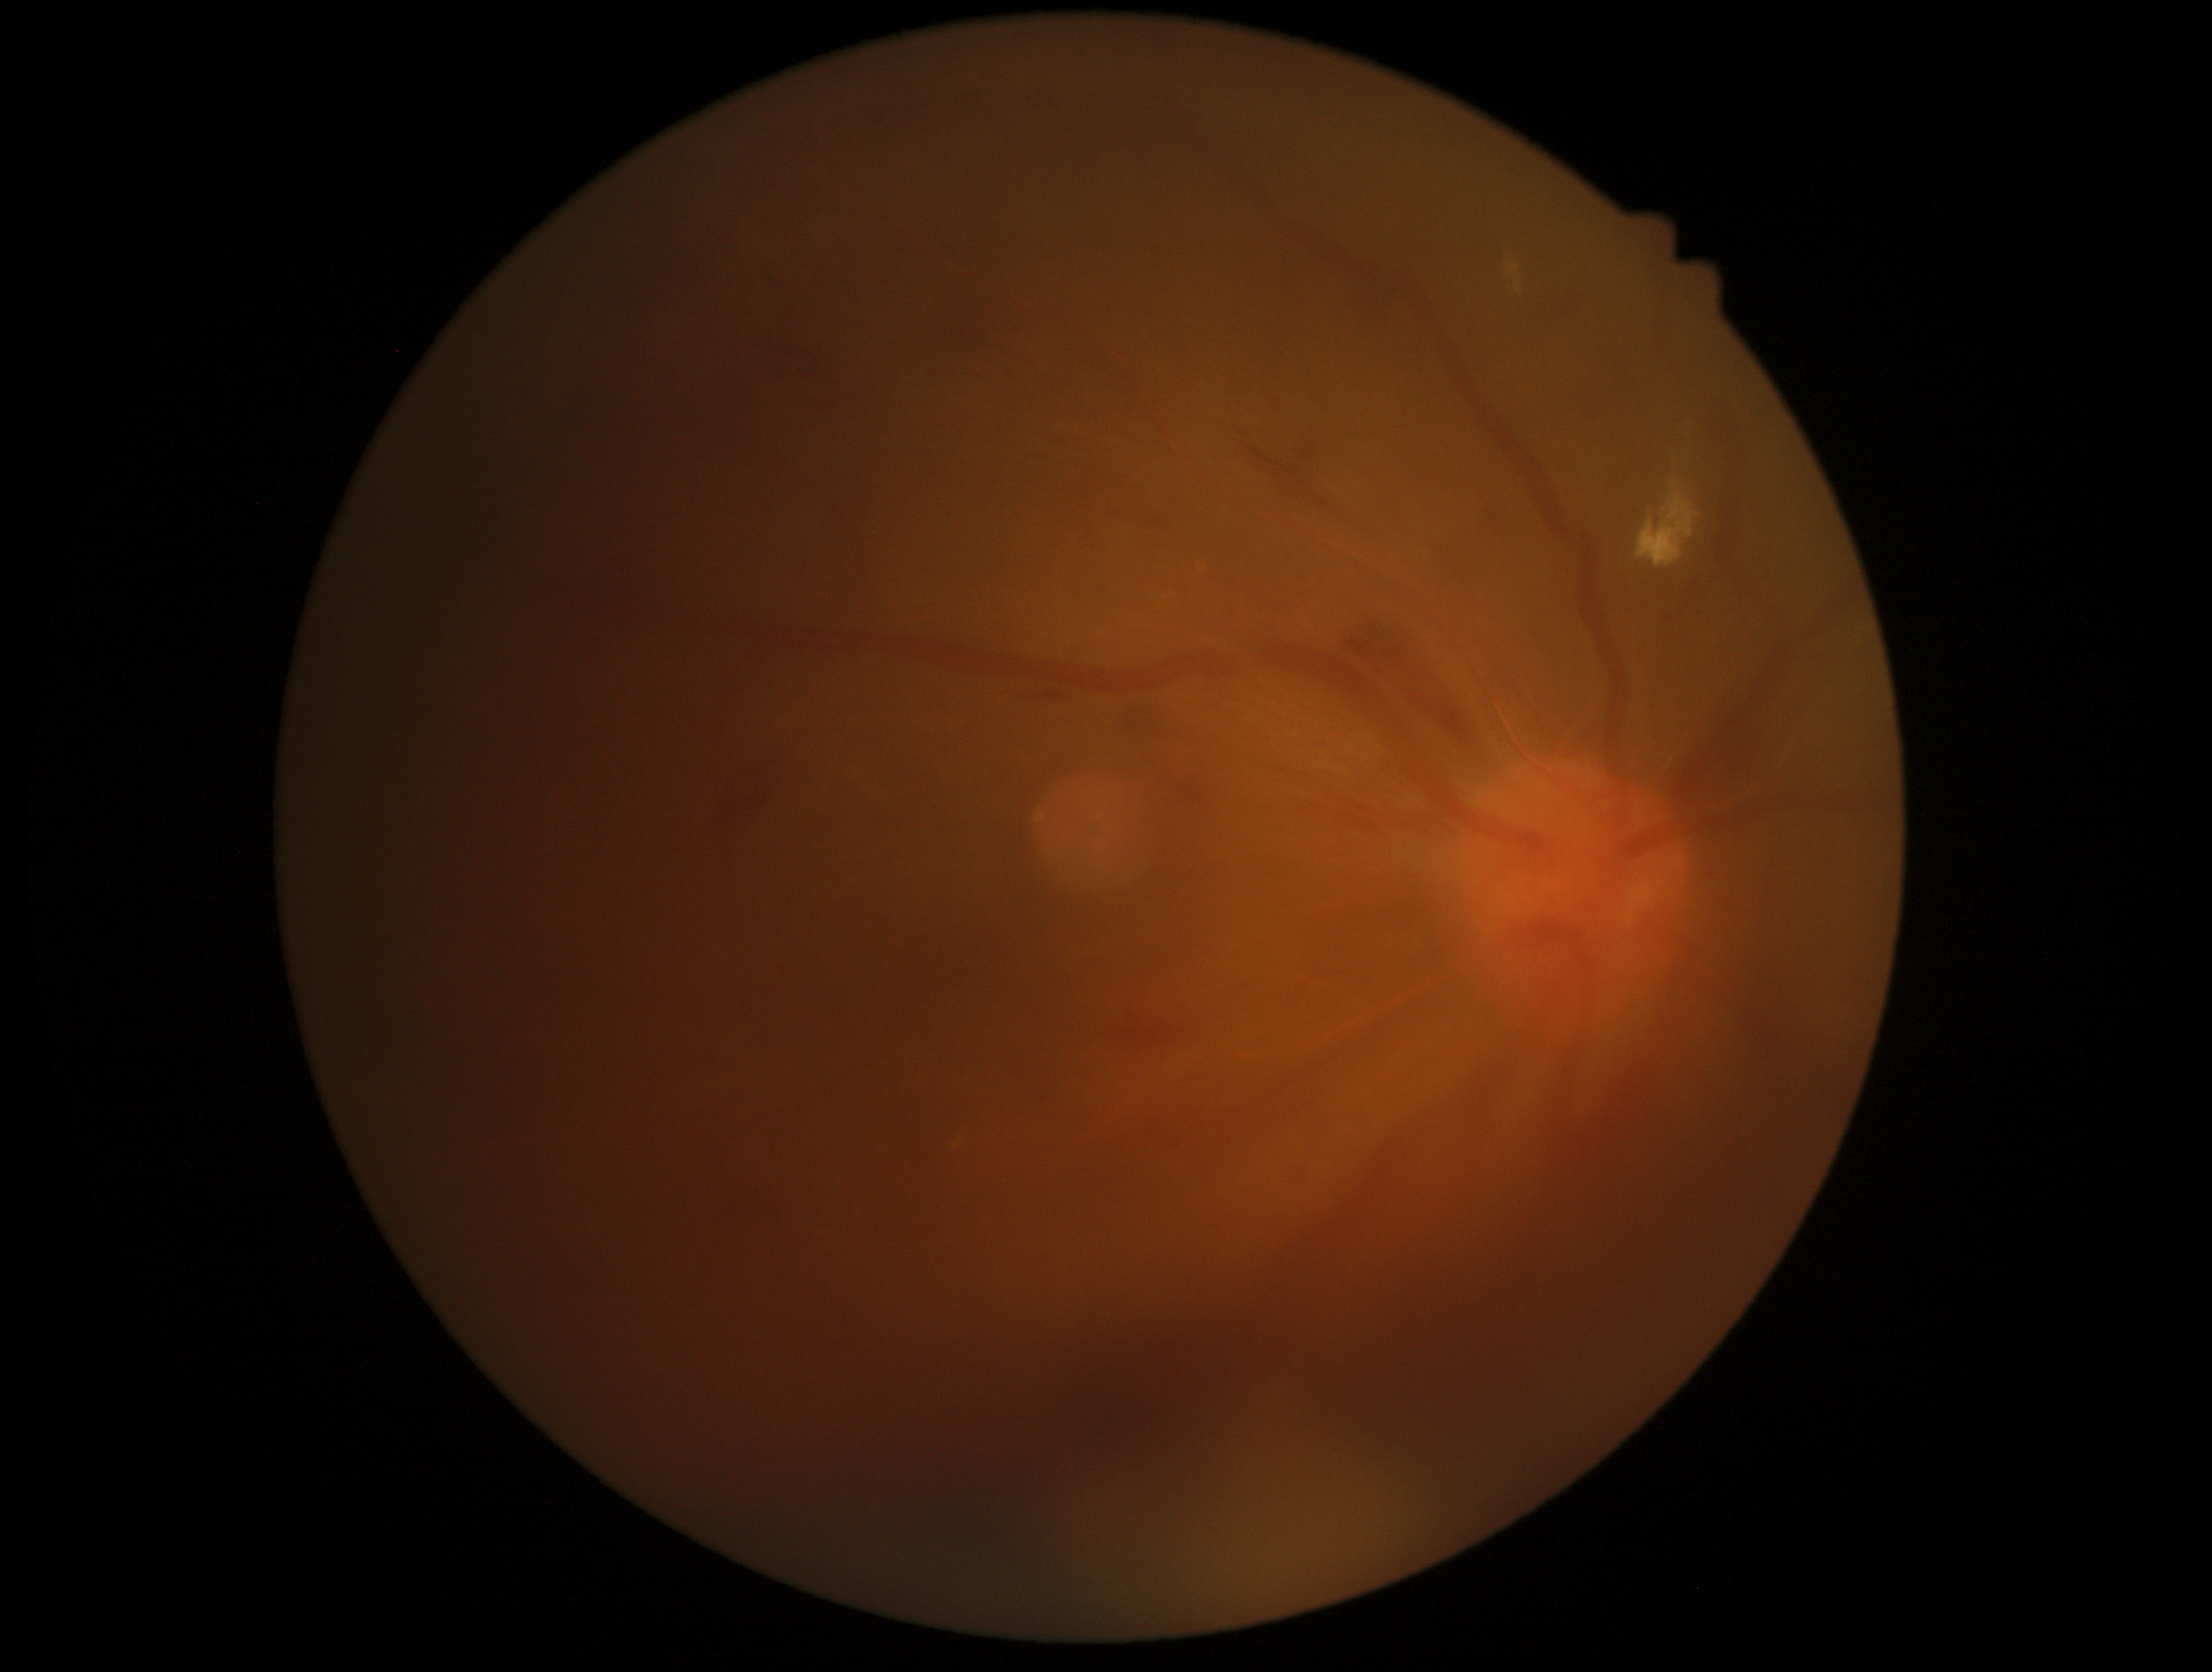 retinopathy grade: 4 — neovascularization and/or vitreous/pre-retinal hemorrhage.